Image size 2184x1690: 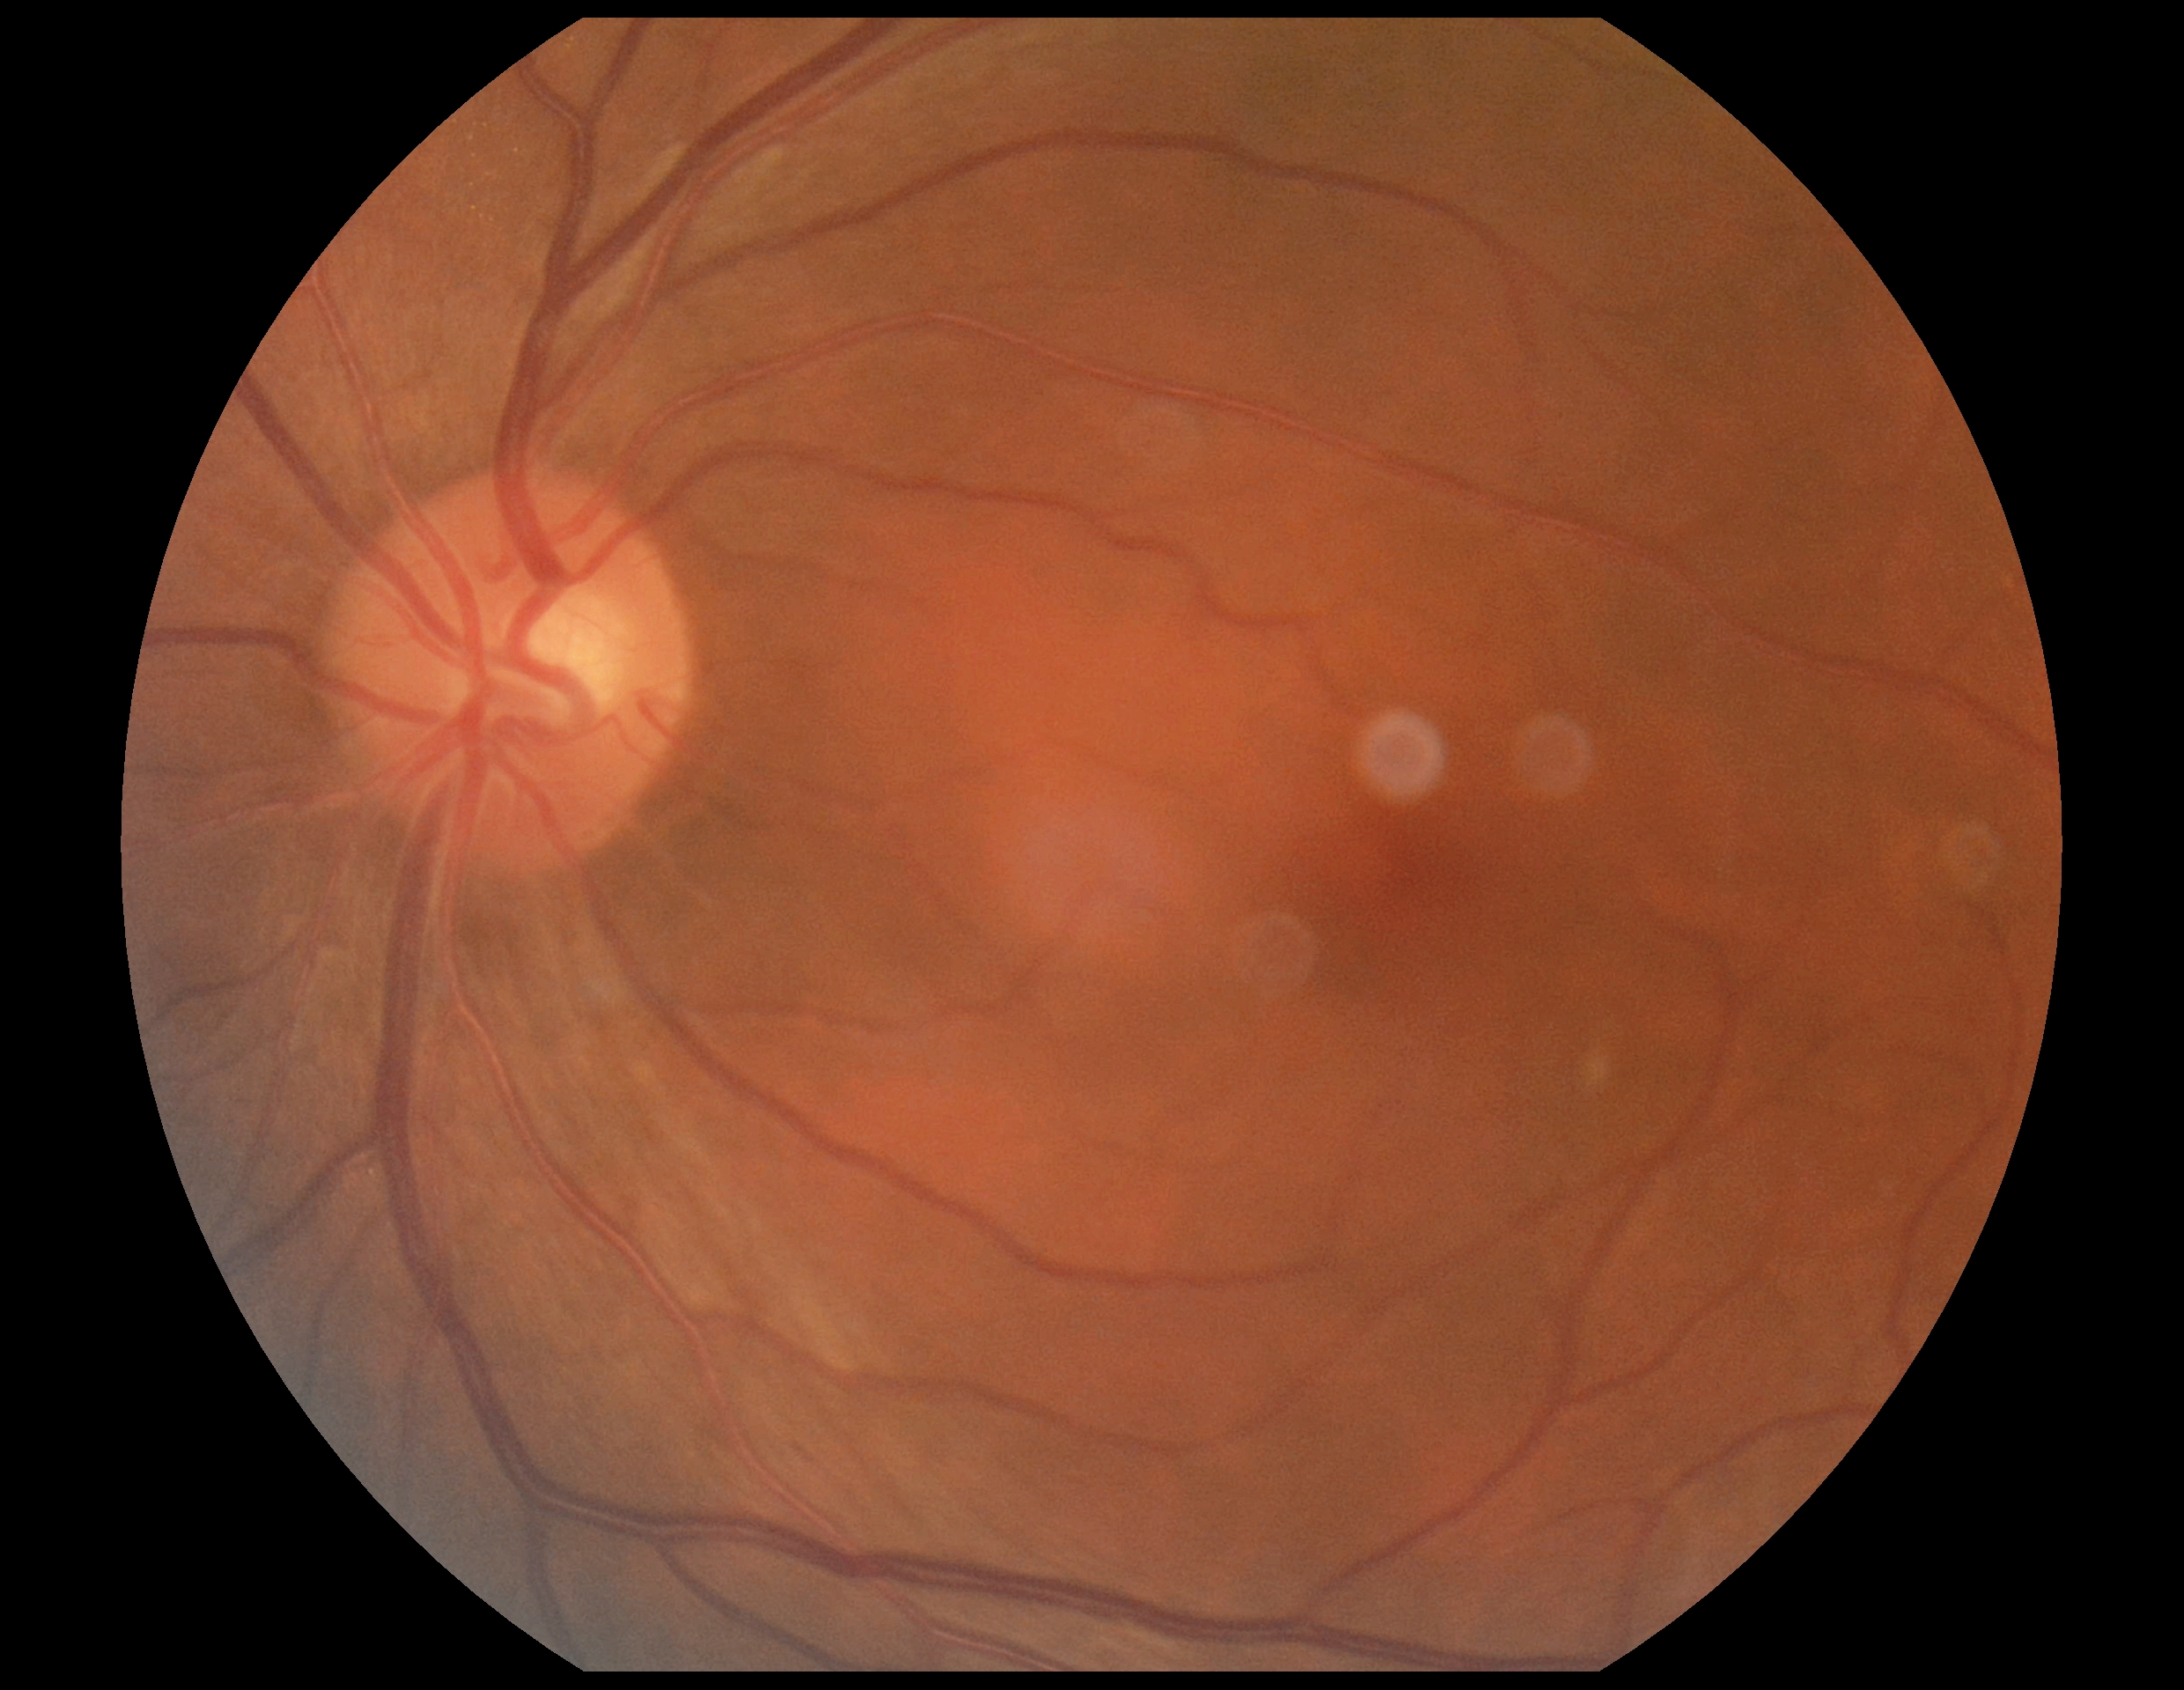

No DR findings.
Diabetic retinopathy severity: 0.